Wide-field fundus photograph of an infant. 130° field of view (Clarity RetCam 3).
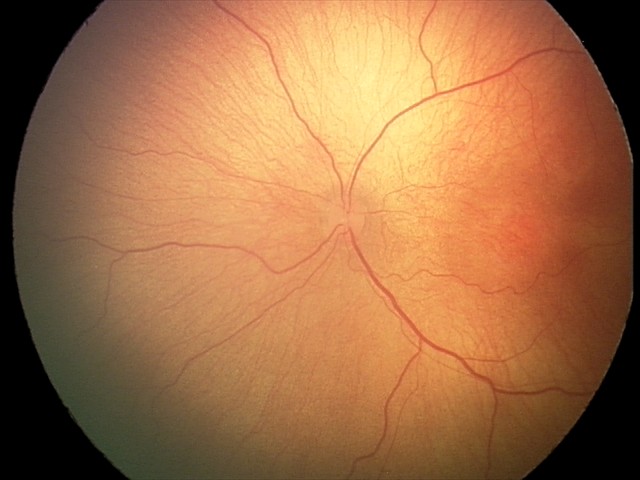 Screening diagnosis = ROP stage 2.